Retinal fundus photograph · image size 1932x1916 — 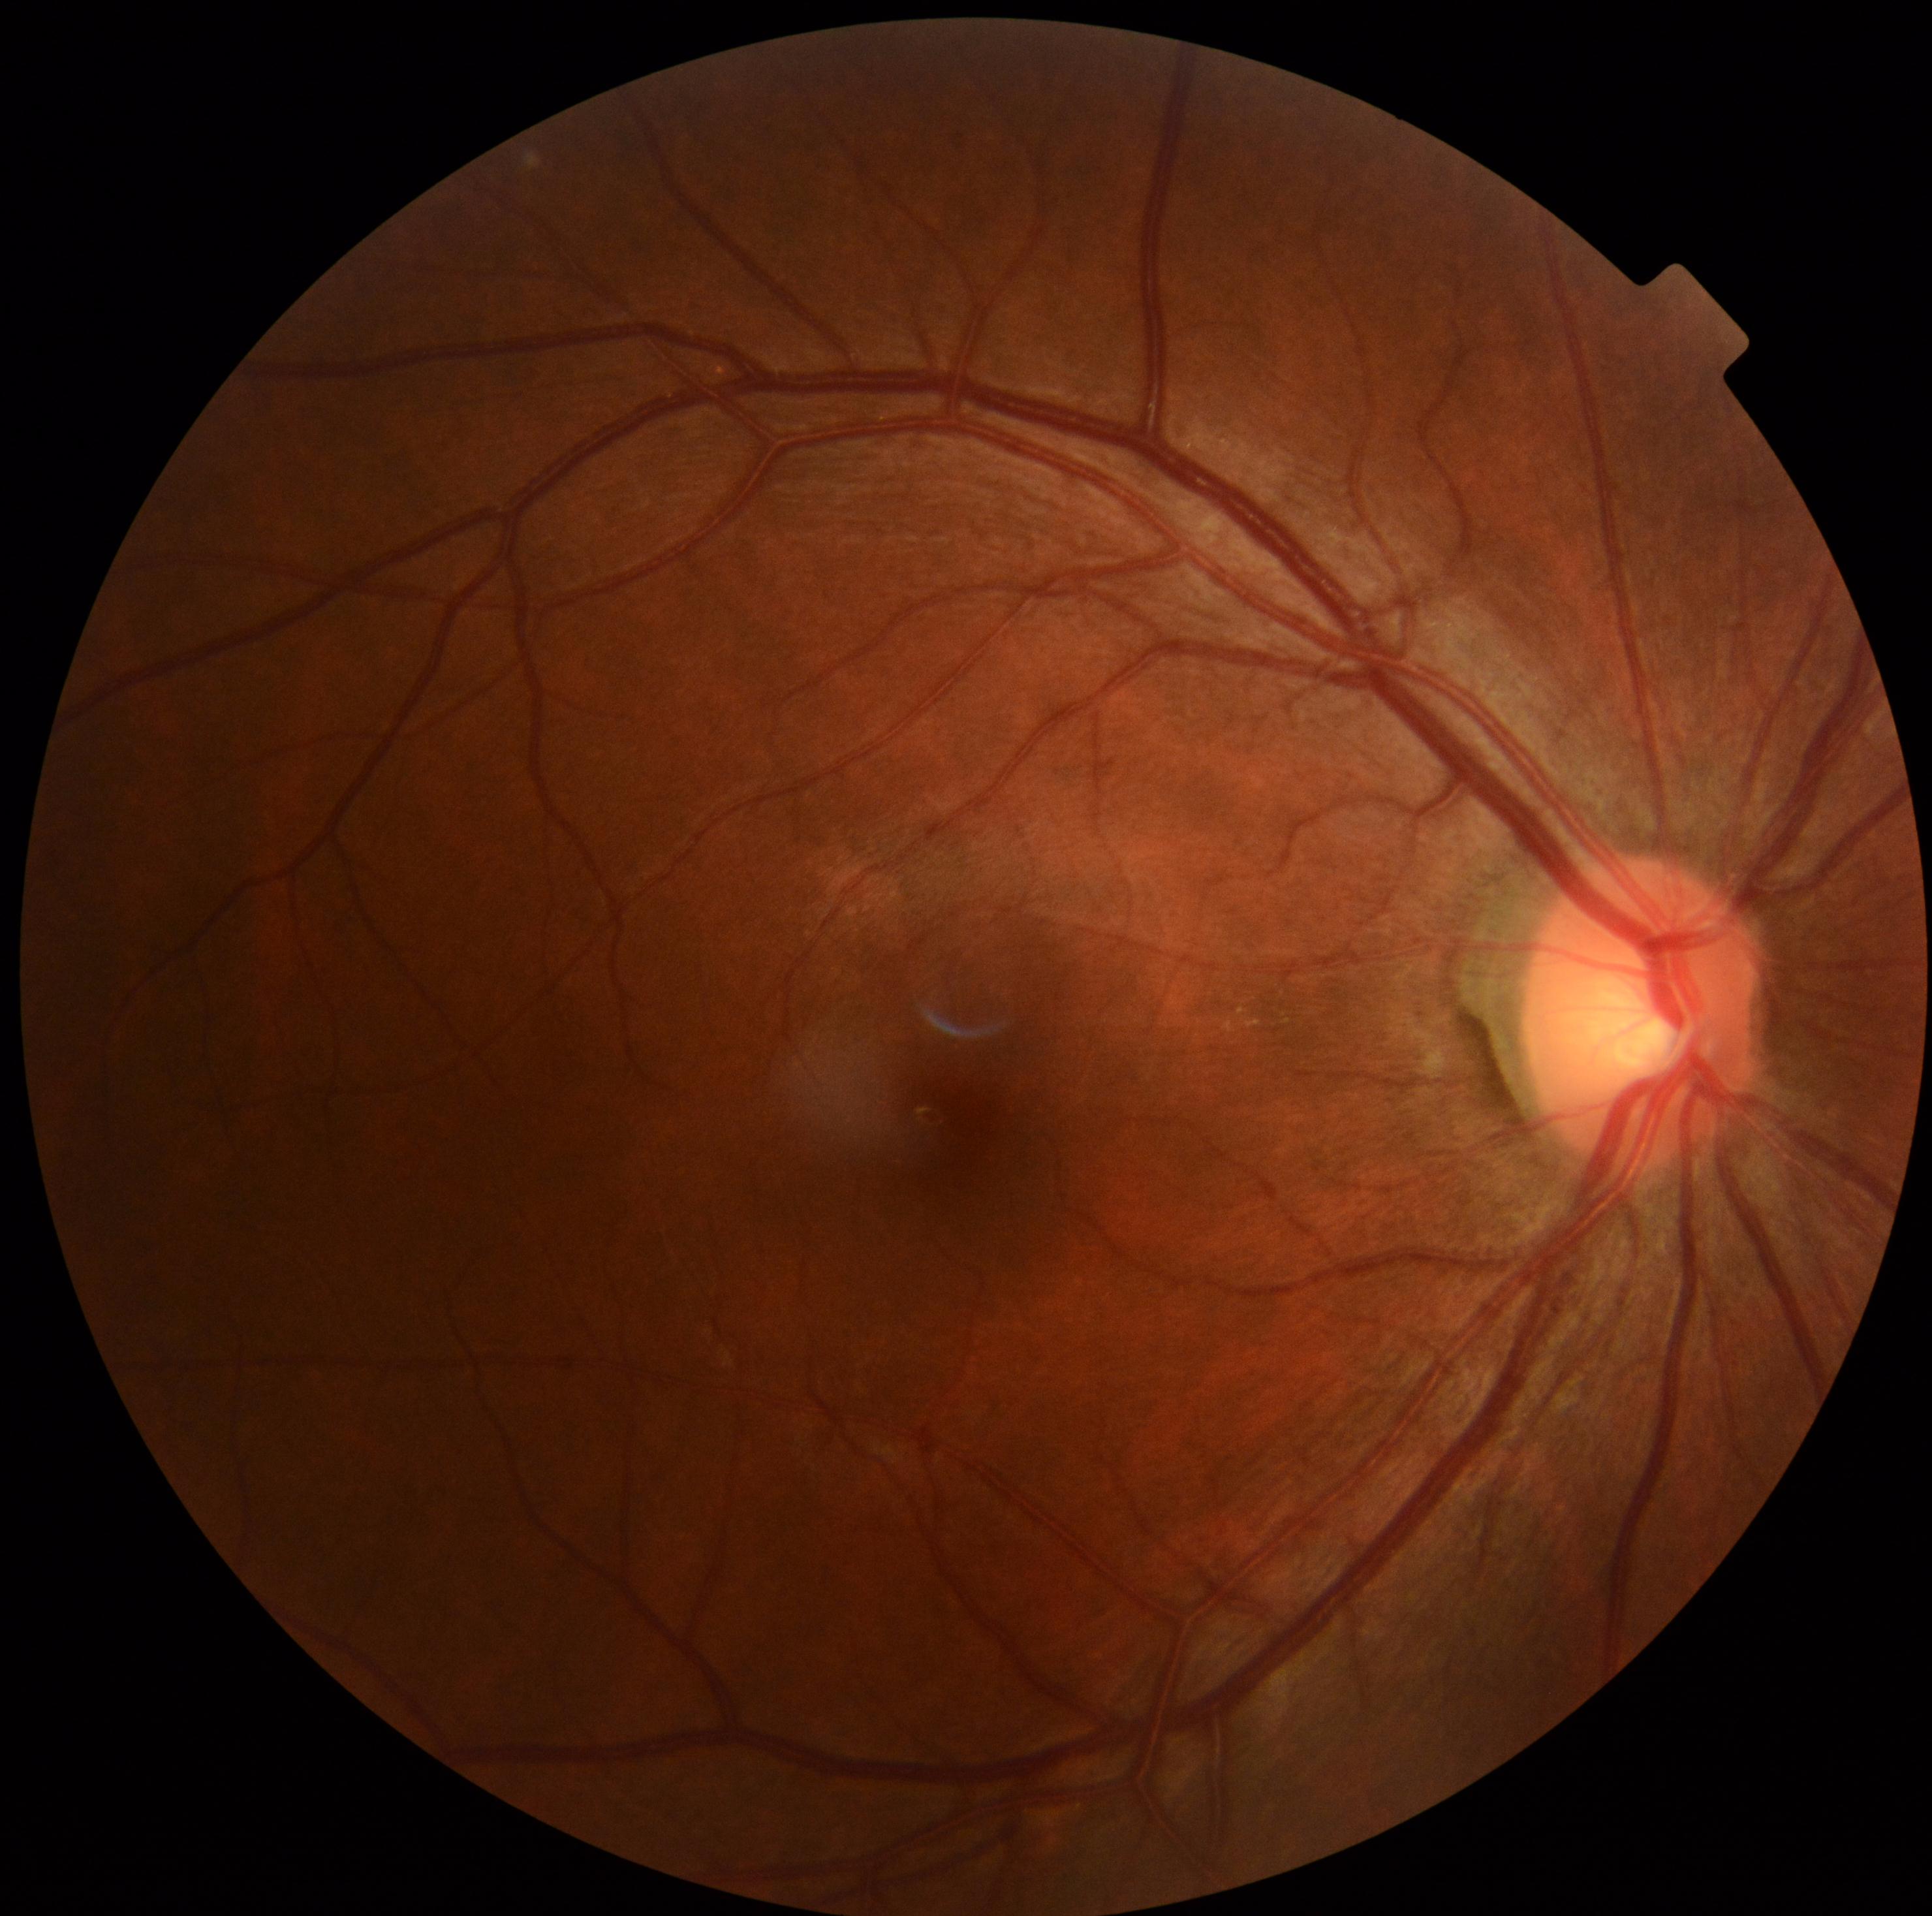
No DR findings. DR stage is 0.